Modified Davis classification: 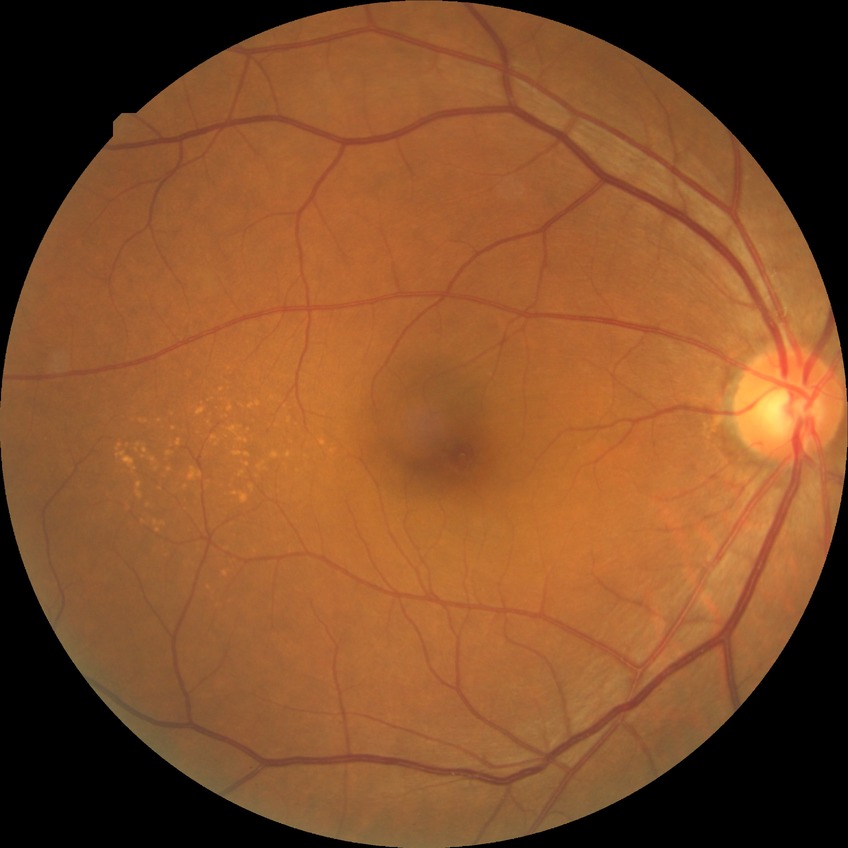   davis_grade: no diabetic retinopathy